FOV: 45 degrees
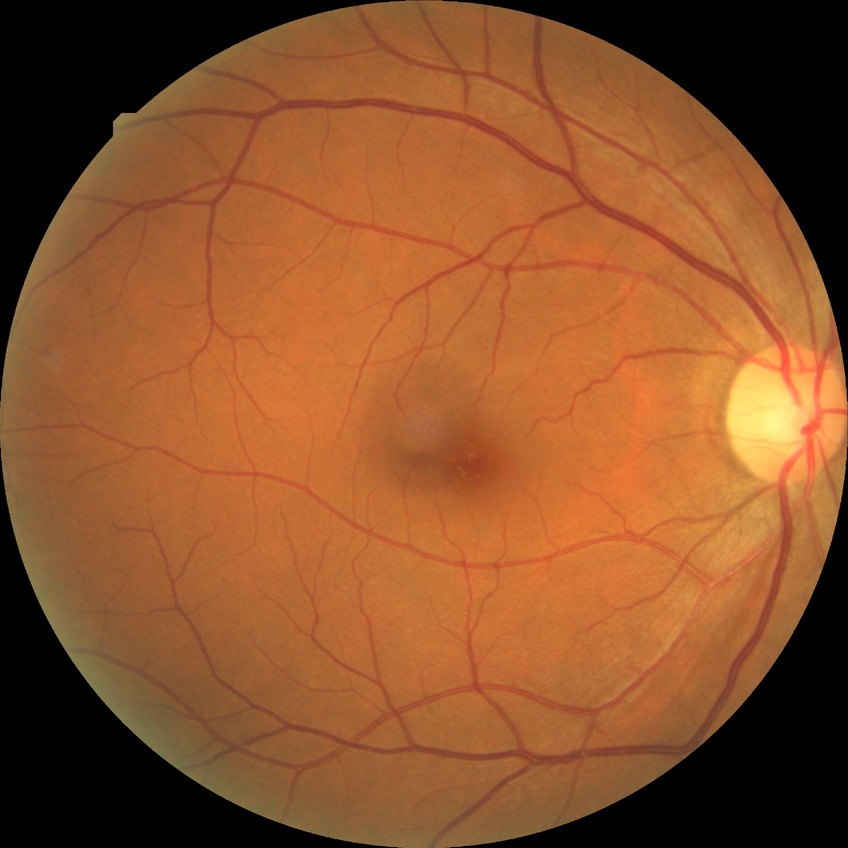 Diabetic retinopathy (DR): no diabetic retinopathy (NDR).